Without pupil dilation, diabetic retinopathy graded by the modified Davis classification: 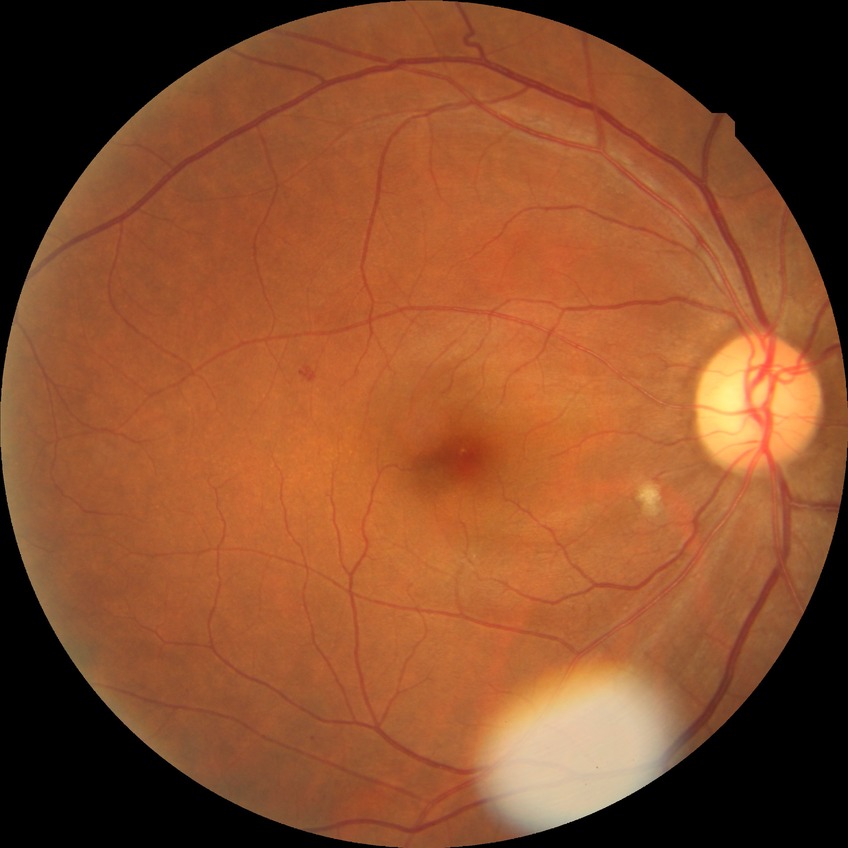   davis_grade: pre-proliferative diabetic retinopathy